RetCam wide-field infant fundus image · image size 1440x1080: 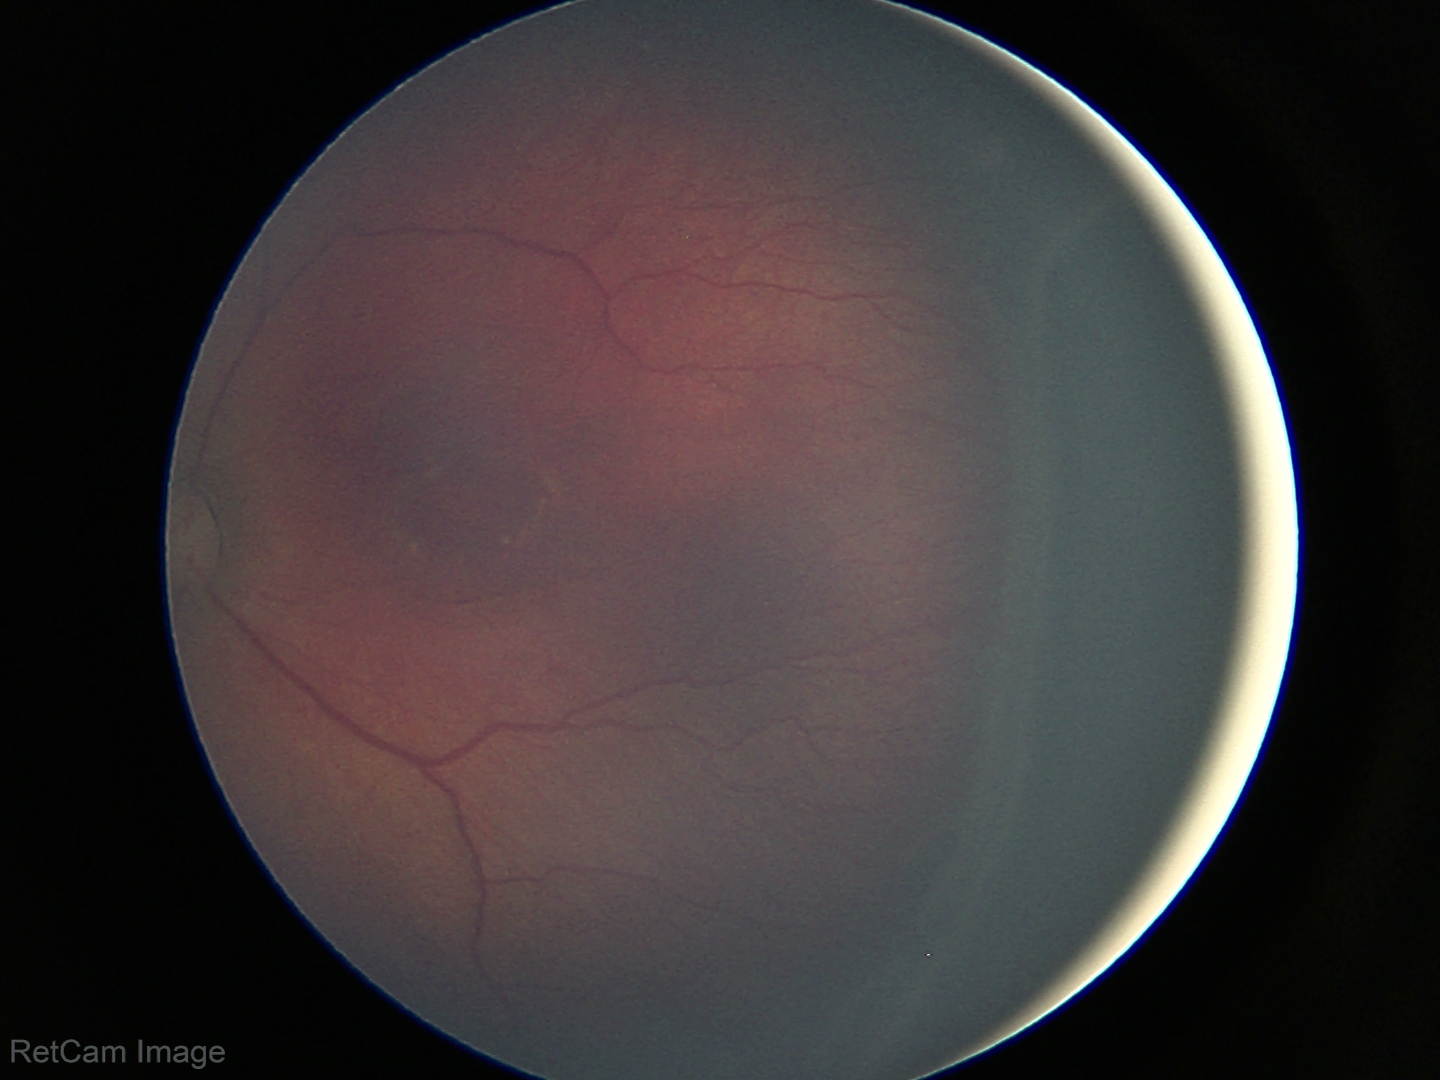

Q: Is plus disease present?
A: no plus disease
Q: What is the diagnosis from this examination?
A: ROP stage 3